DR severity per modified Davis staging · CFP
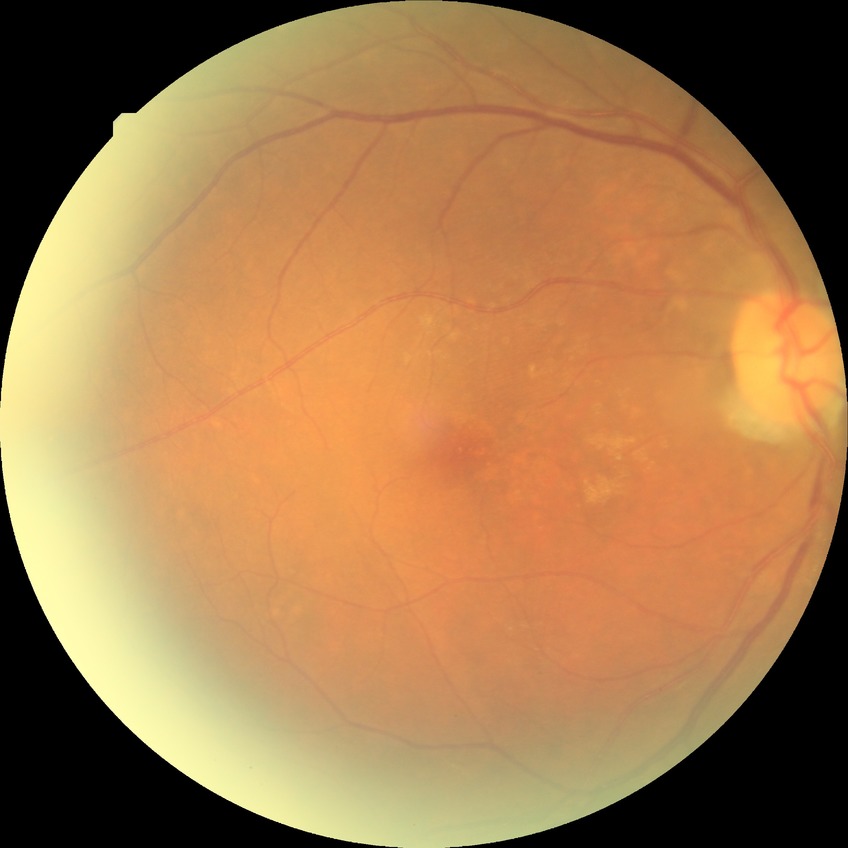

diabetic retinopathy (DR): no diabetic retinopathy (NDR).